Modified Davis grading. Acquired with a NIDEK AFC-230:
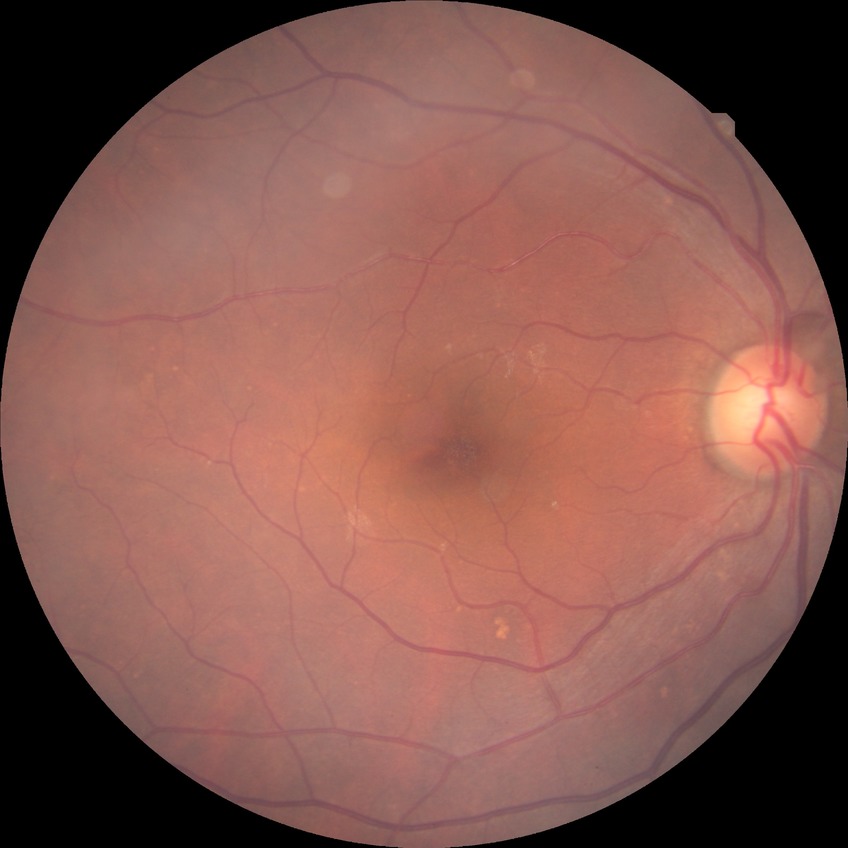

Davis grading=no diabetic retinopathy.